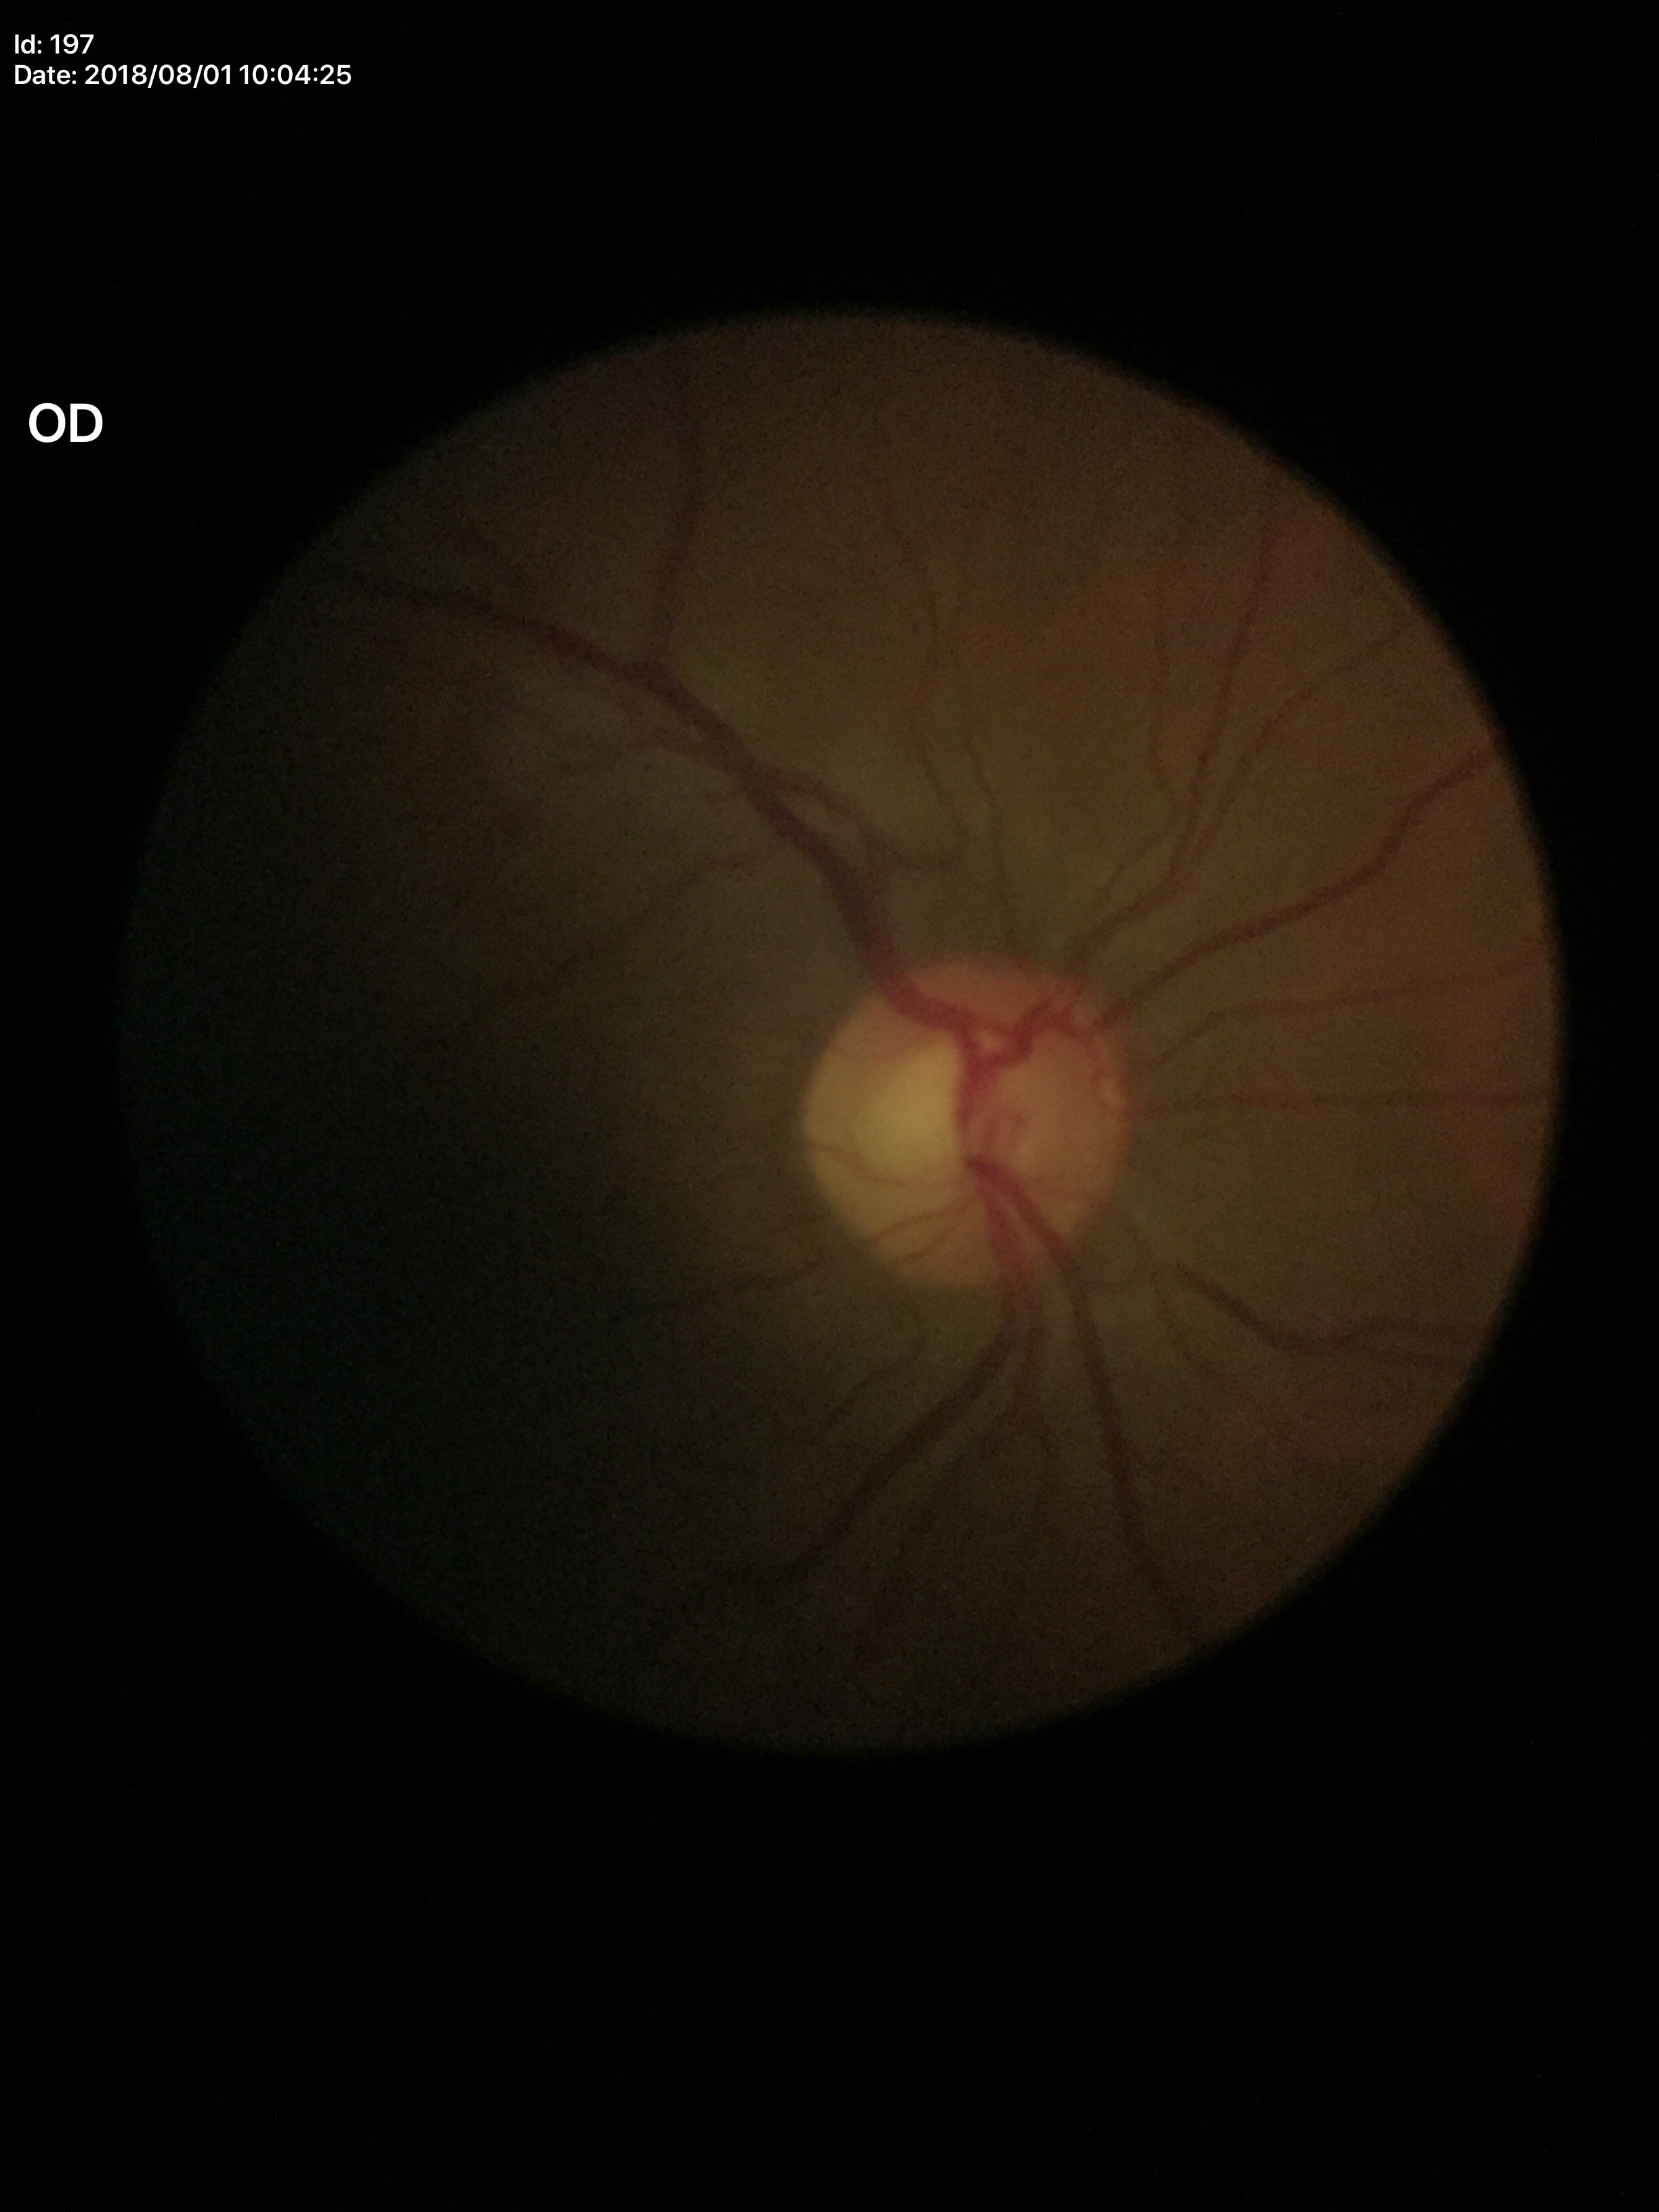
{
  "glaucoma_decision": "not suspect (unanimous normal call)",
  "vcdr": "0.54"
}